45 degree fundus photograph · modified Davis grading · camera: NIDEK AFC-230
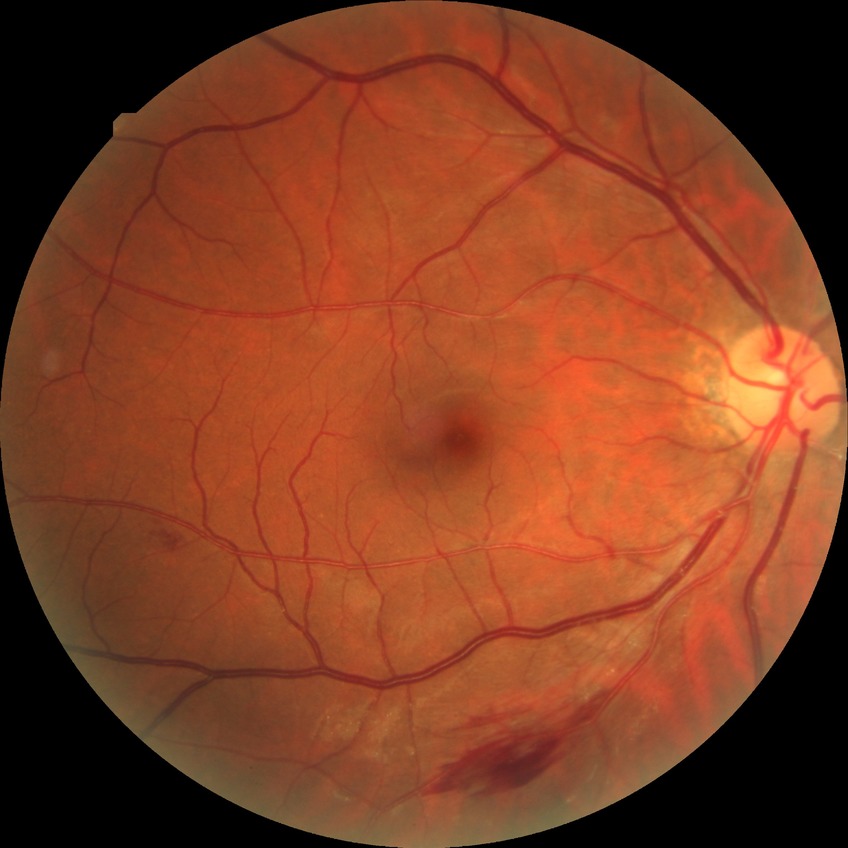
davis_grade: simple diabetic retinopathy (SDR)